Modified Davis classification: 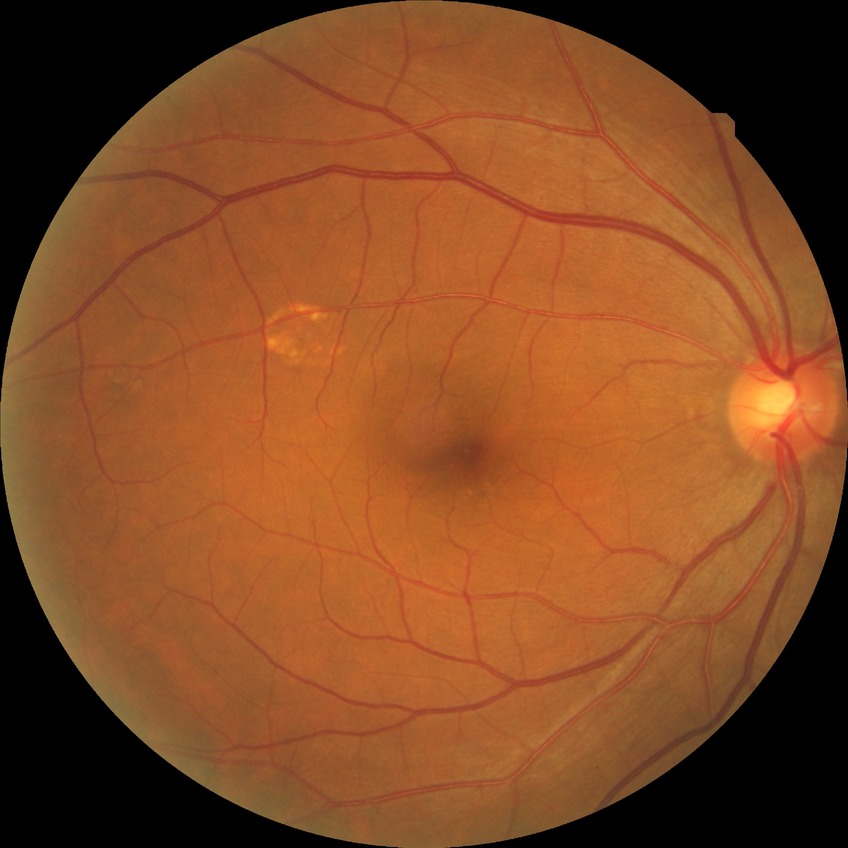 diabetic retinopathy (DR): NDR (no diabetic retinopathy)